45° field of view, color fundus photograph, 2048 x 1536 pixels.
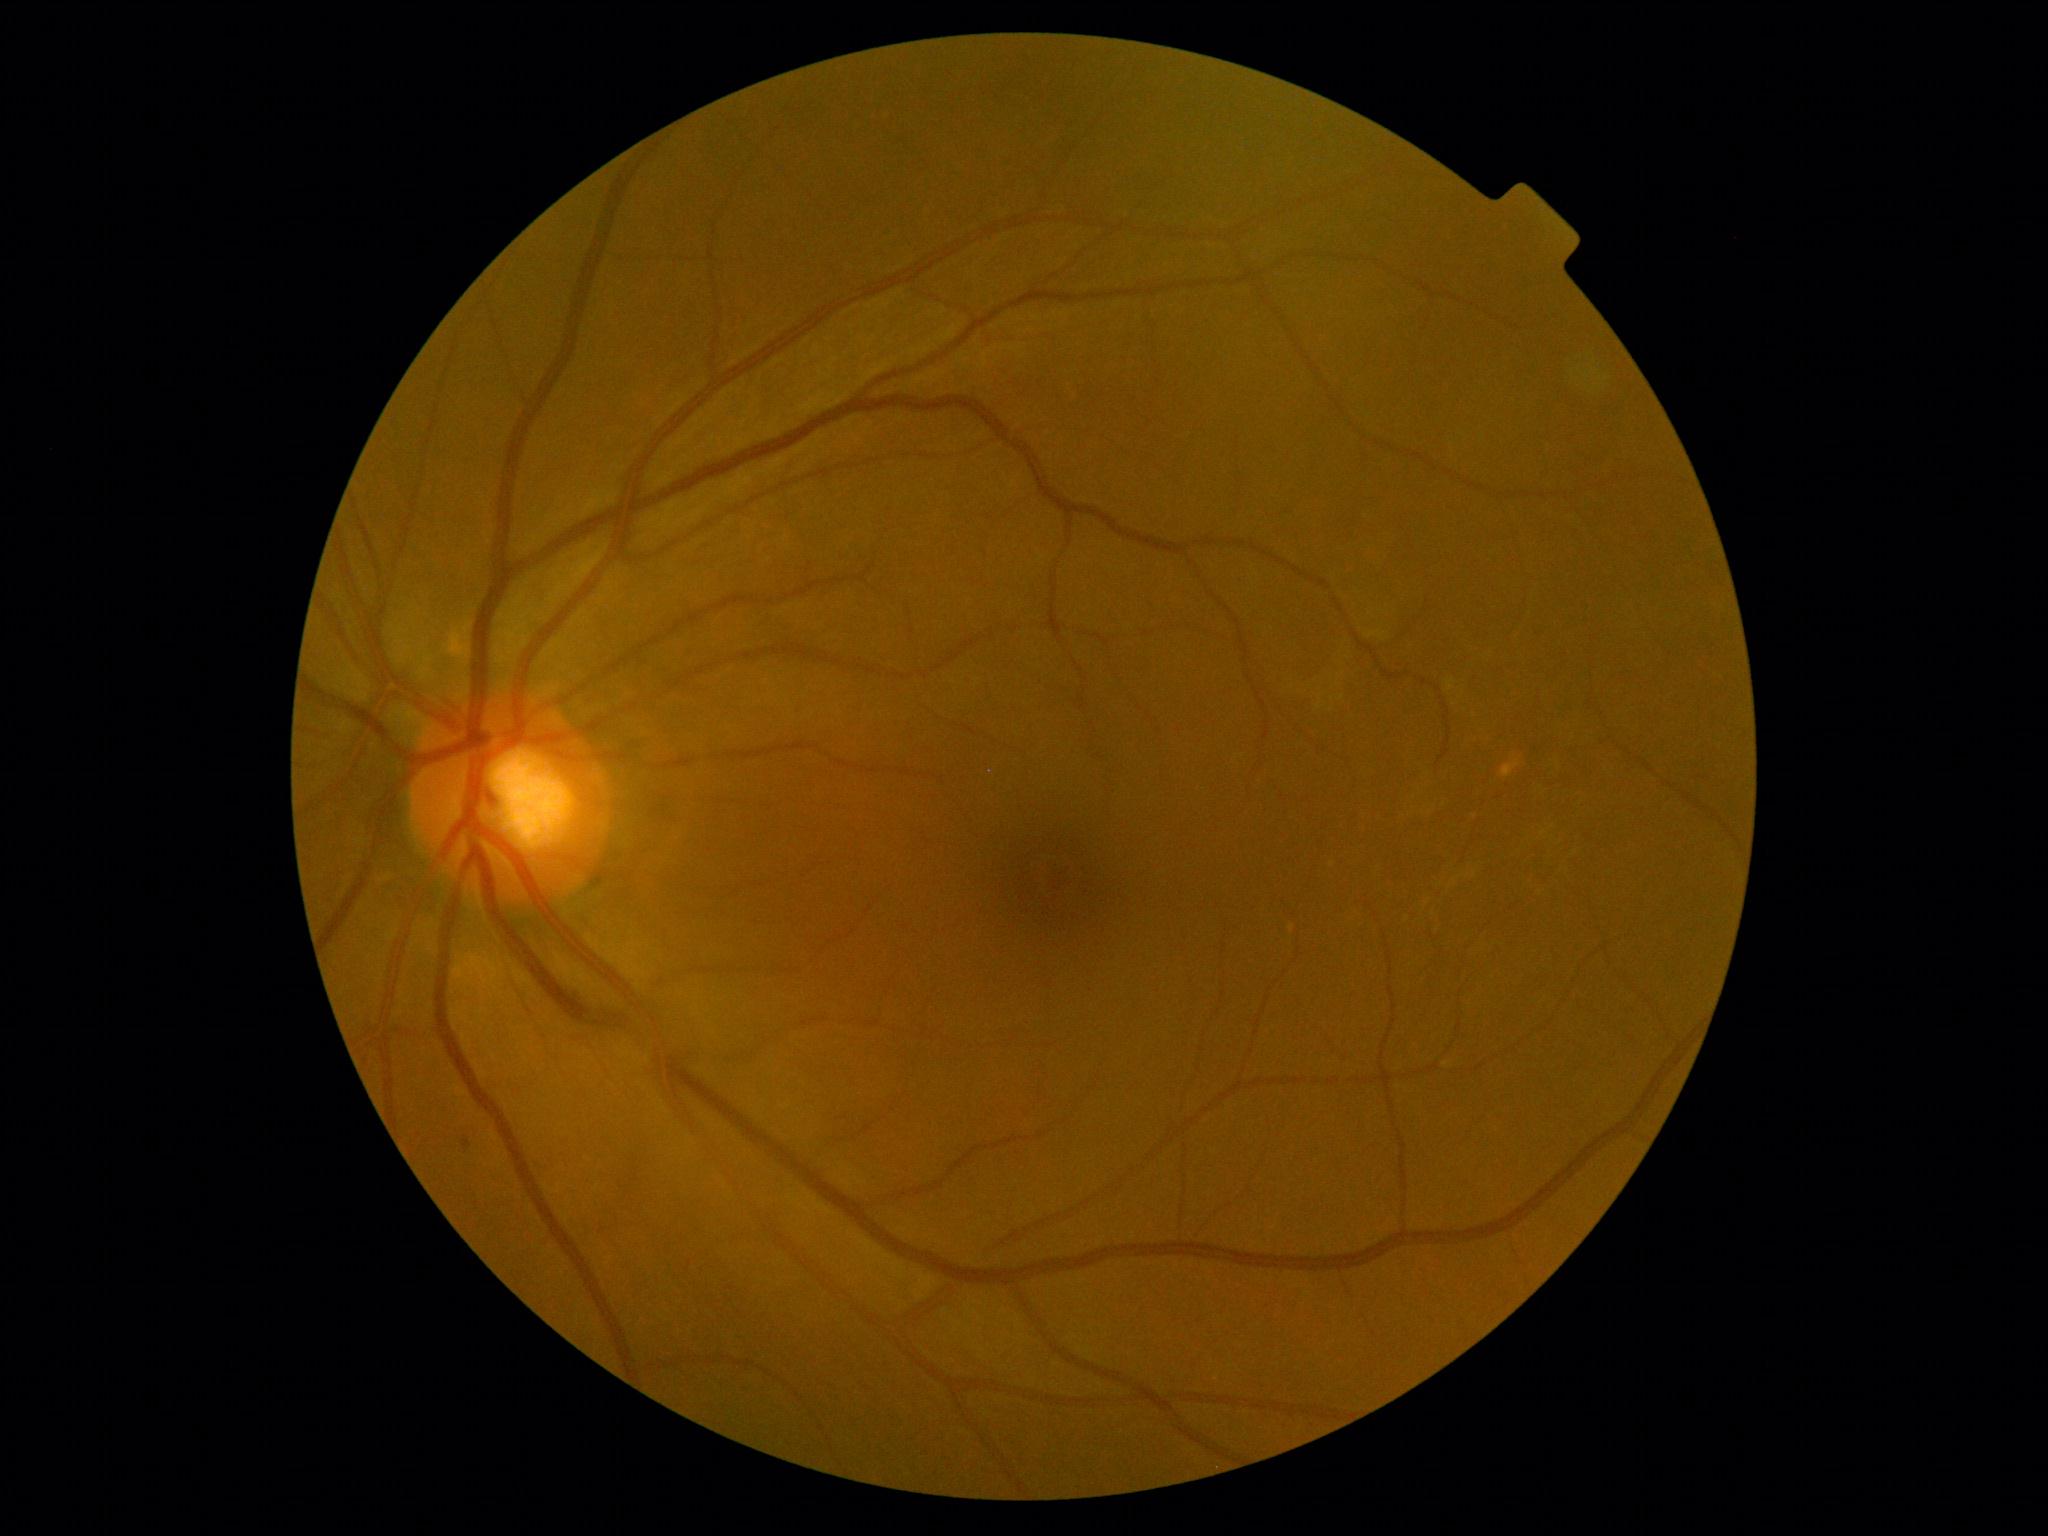
DR severity is mild non-proliferative diabetic retinopathy (grade 1).
DR class: non-proliferative diabetic retinopathy.